848x848. 45-degree field of view: 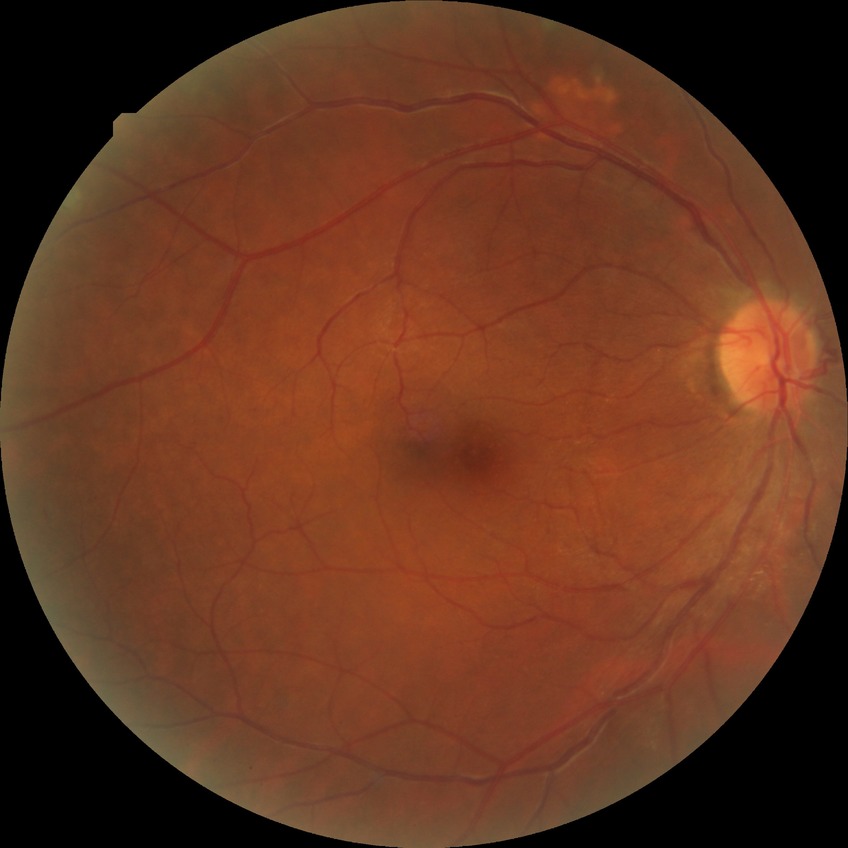 diabetic retinopathy stage = no diabetic retinopathy